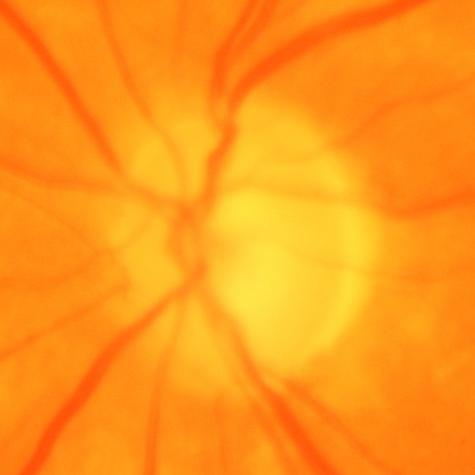 Glaucomatous changes.